Wide-field contact fundus photograph of an infant
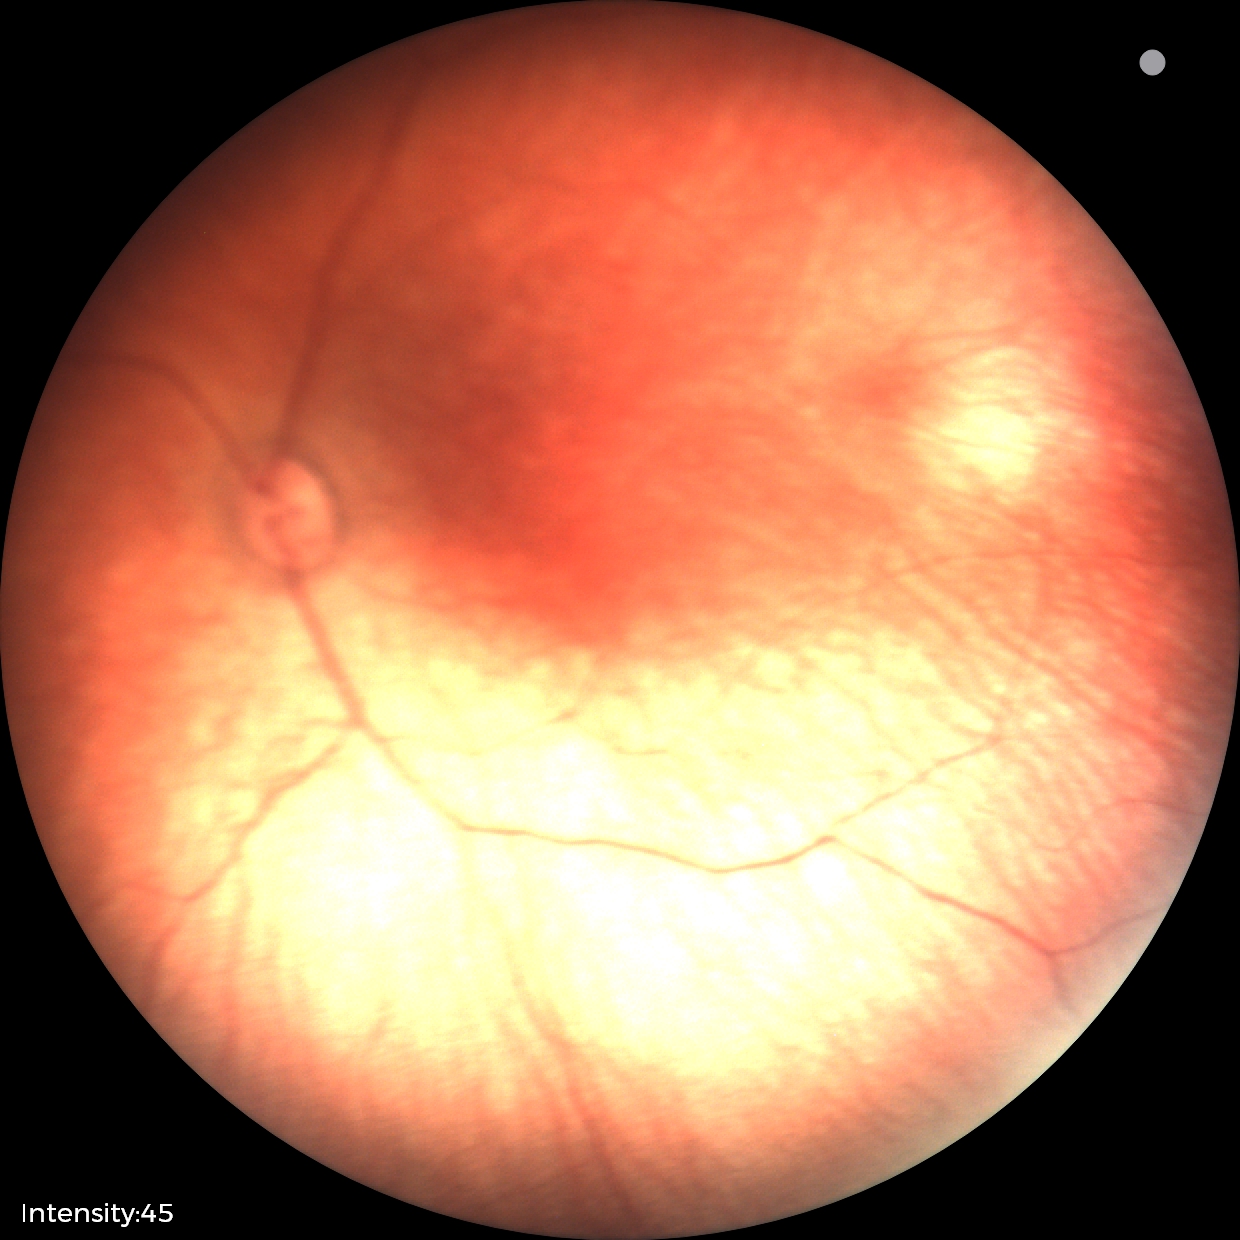
Physiological retinal appearance for postconceptual age.